CFP
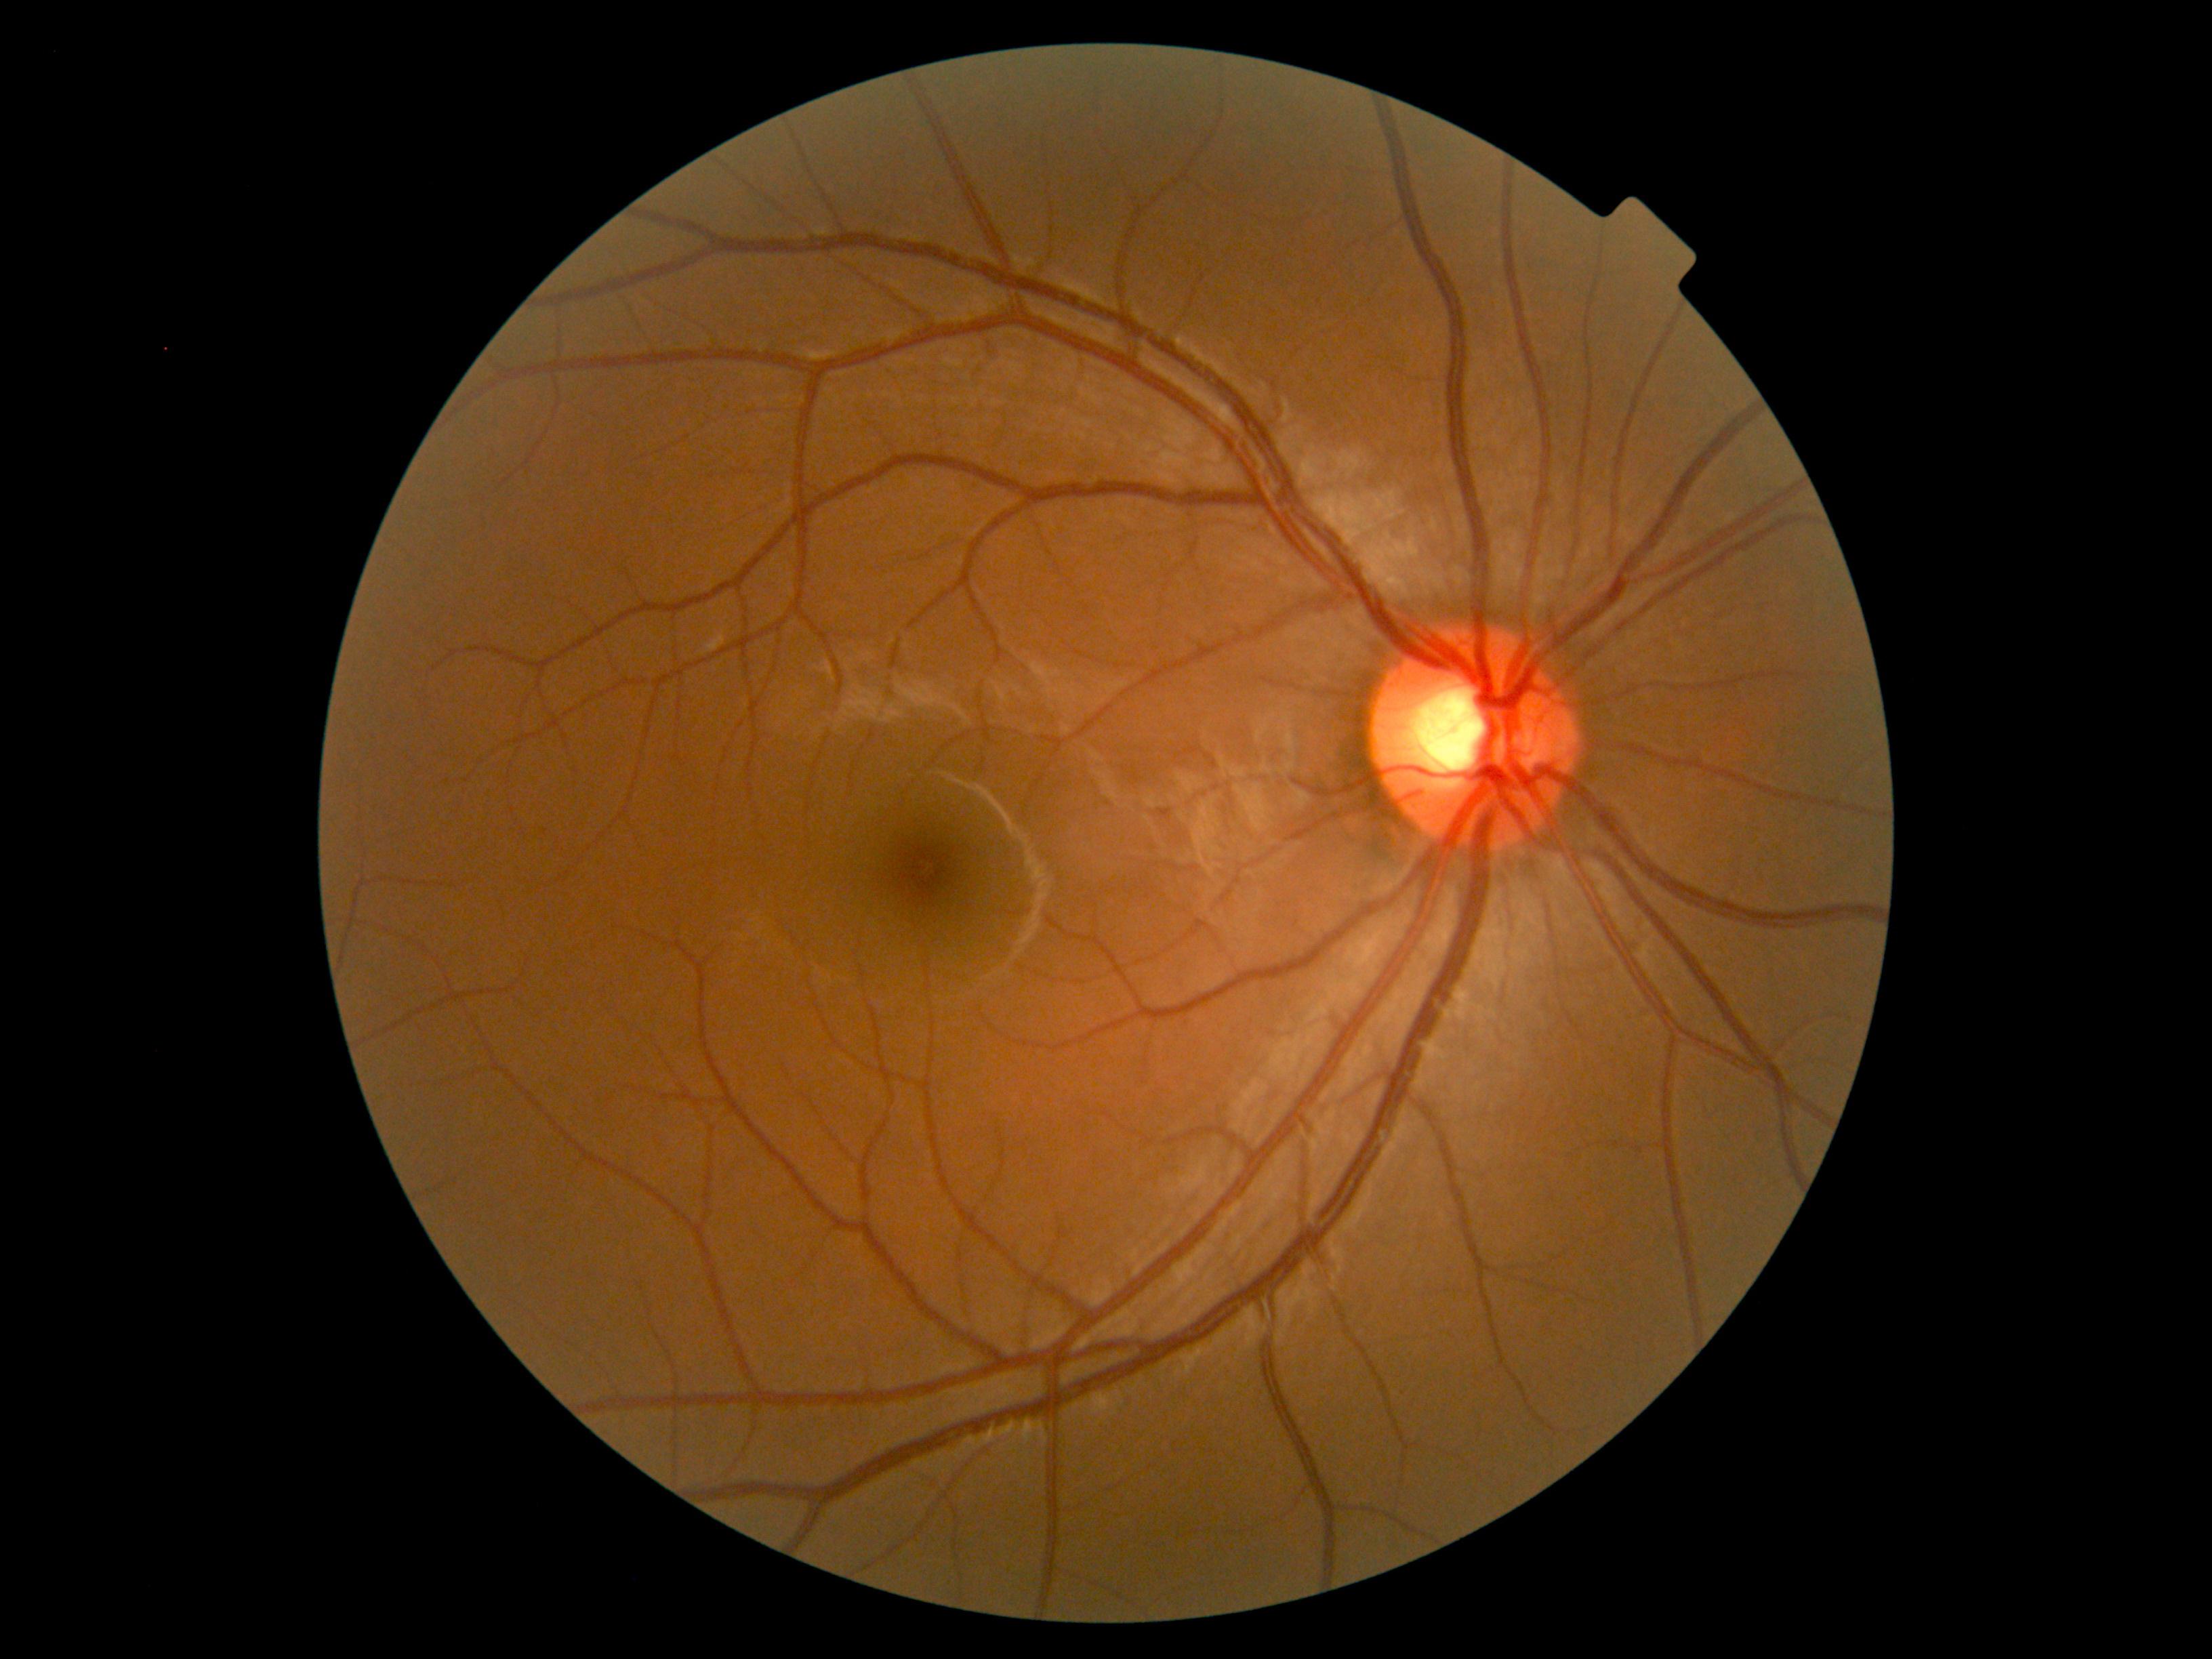 DR grade: no apparent retinopathy (0).